512x512 — 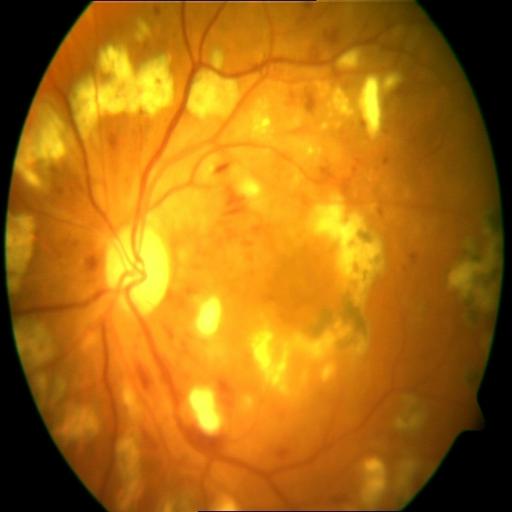
Findings:
- laser scars
- hemorrhagic retinopathy